Posterior pole color fundus photograph:
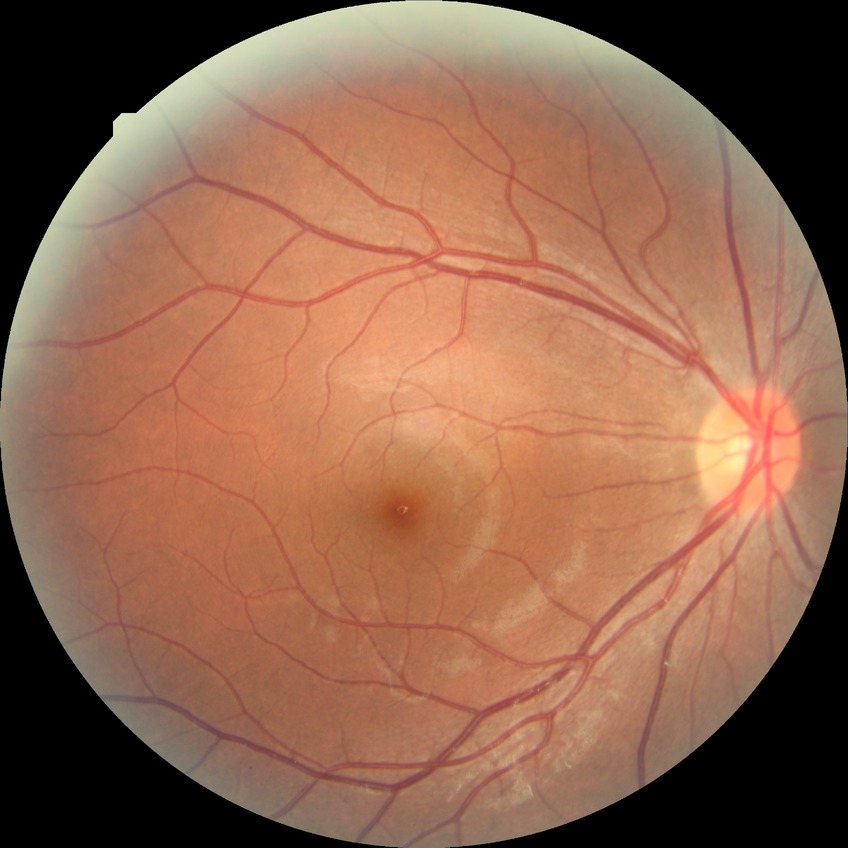

Modified Davis grading is no diabetic retinopathy.